Wide-field fundus photograph from neonatal ROP screening — 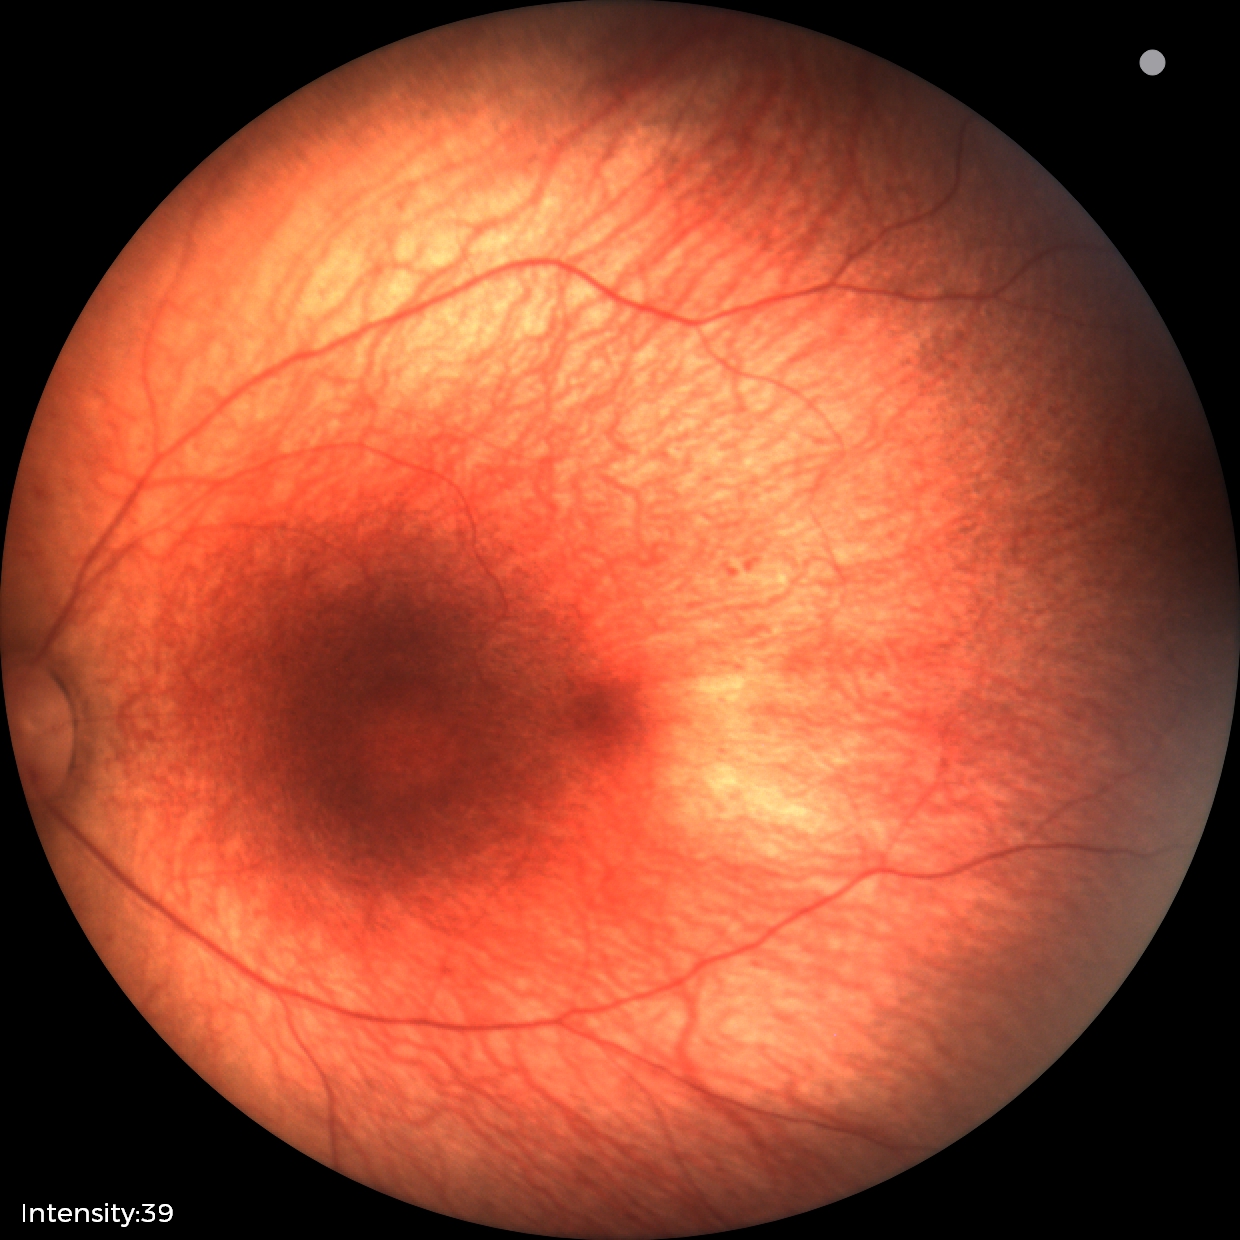 Screening examination diagnosed as physiological.